Davis DR grading — 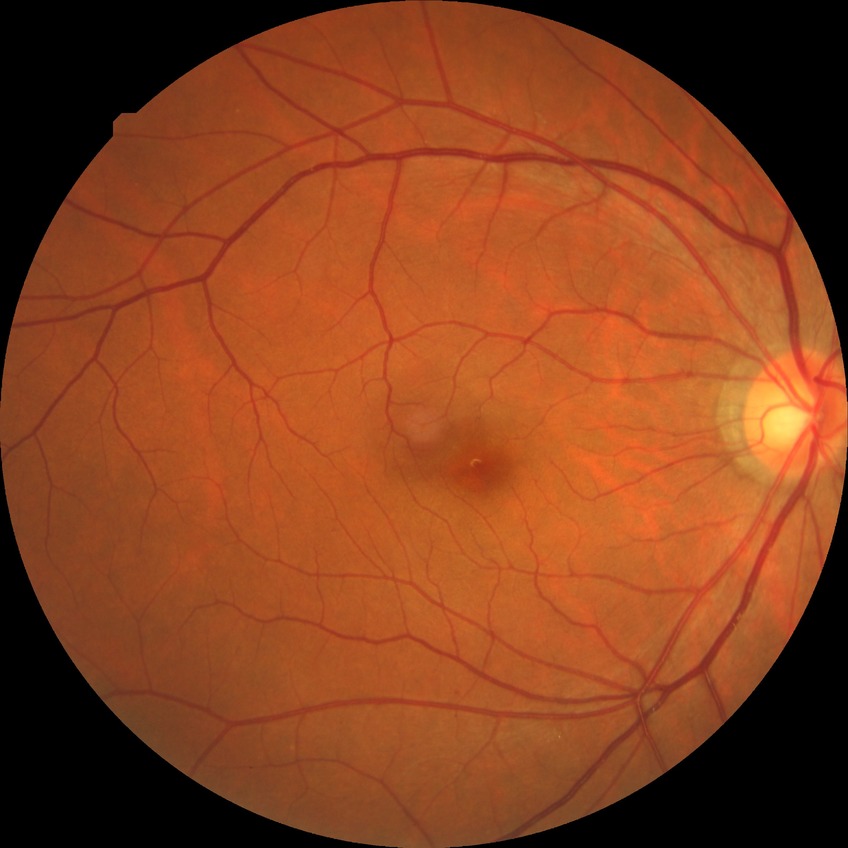
Diabetic retinopathy (DR) is no diabetic retinopathy (NDR).